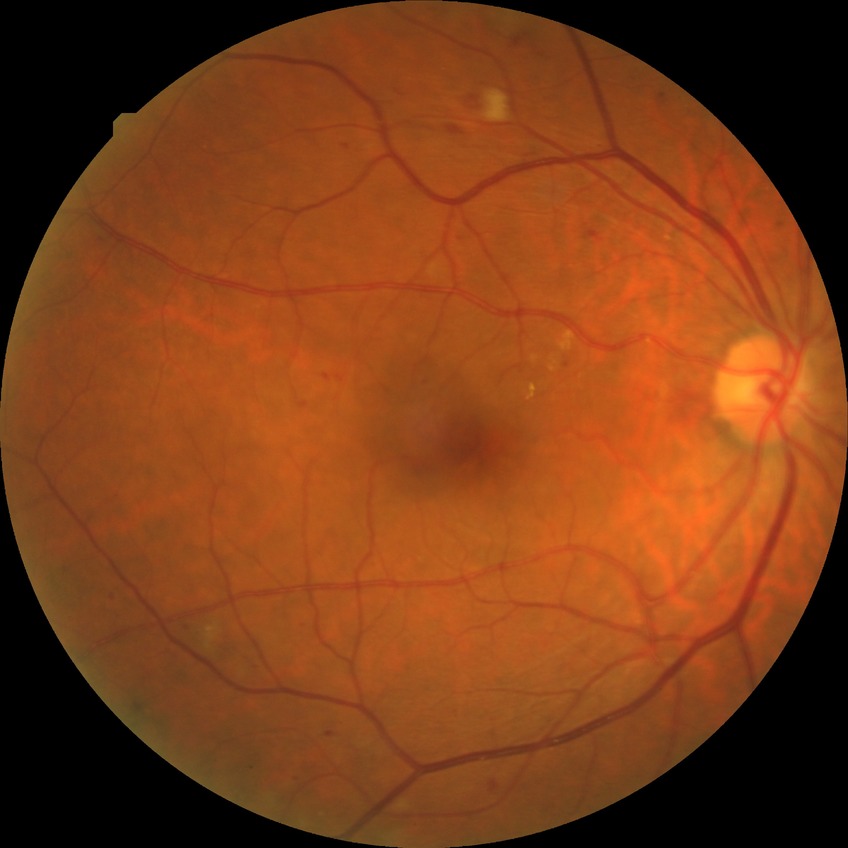
DR class: non-proliferative diabetic retinopathy, diabetic retinopathy (DR): pre-proliferative diabetic retinopathy (PPDR).